Disc-centered fundus crop, mydriatic:
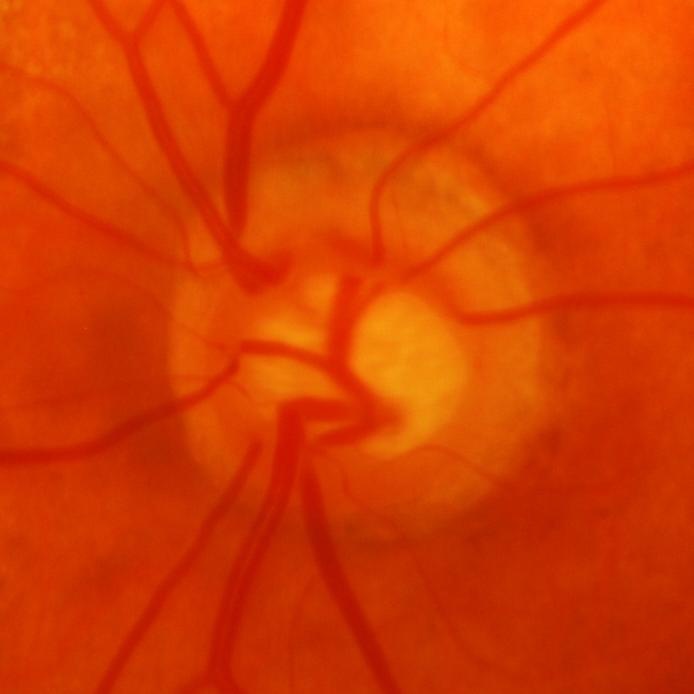
Glaucoma is present. Showing glaucomatous damage to the optic nerve.